2212x1659. 45° FOV — 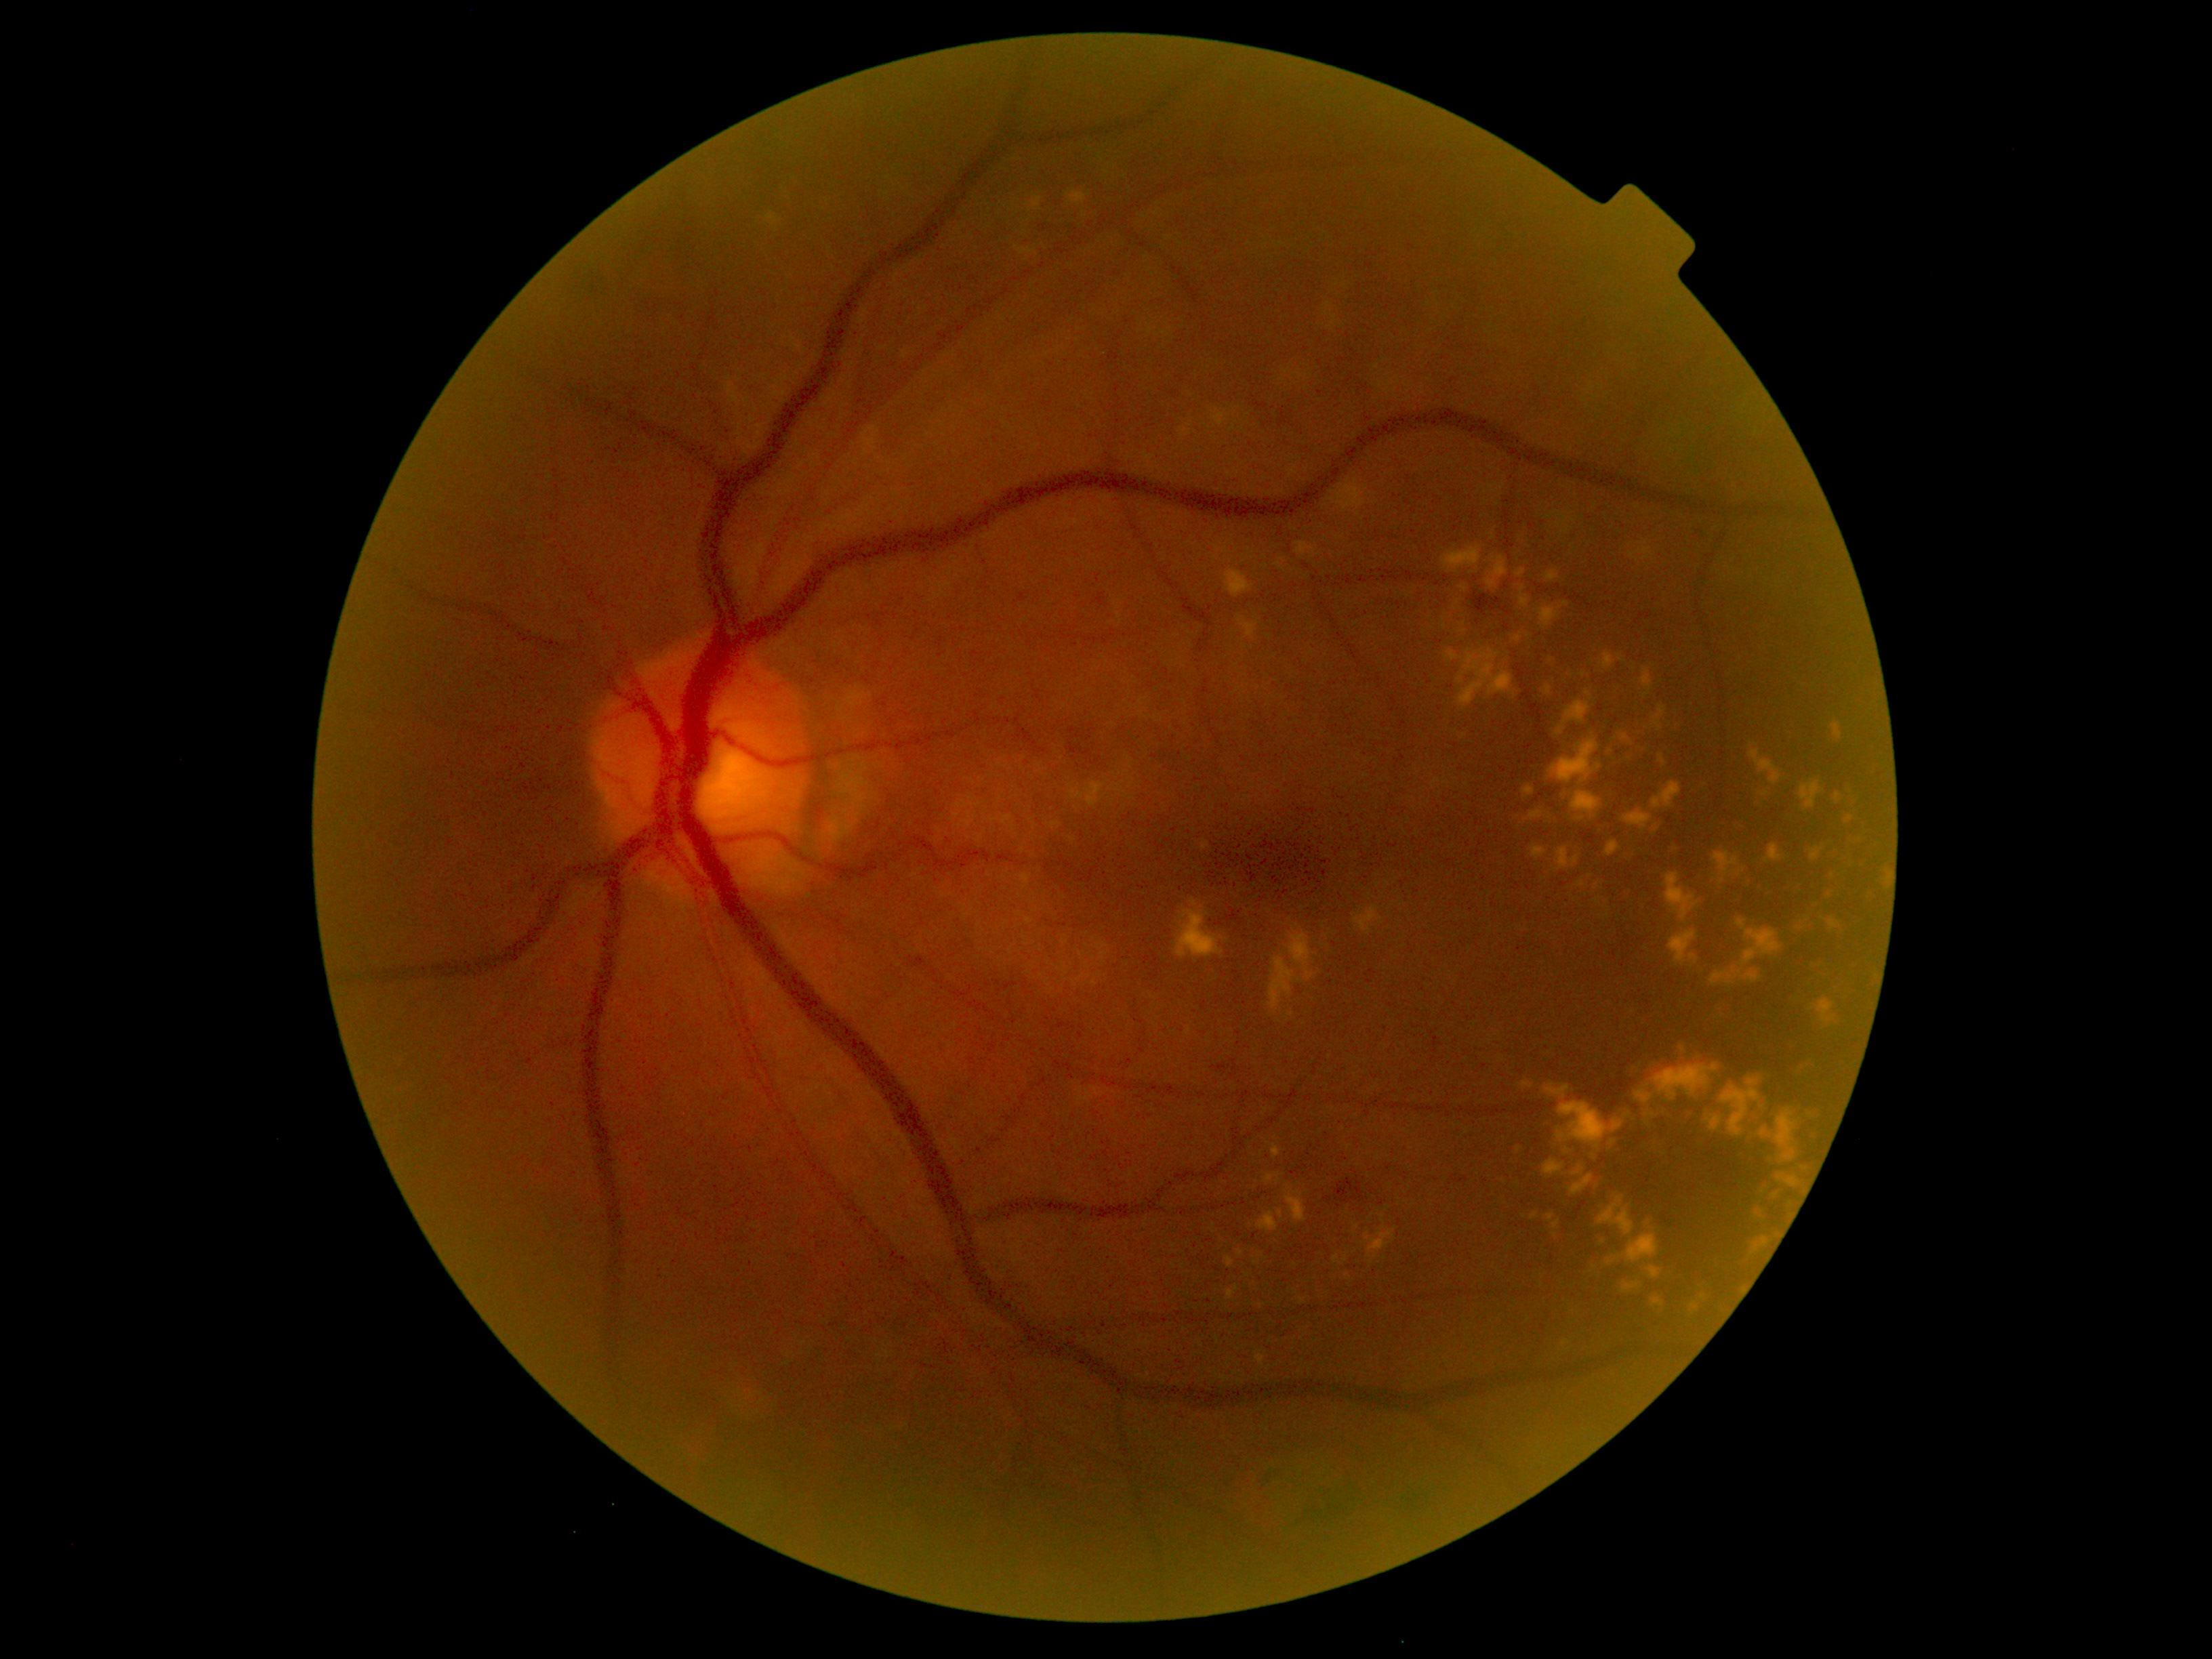
{"partial": true, "dr_grade": 2, "lesions": {"ex": [[1565, 669, 1586, 685], [766, 213, 779, 224], [1212, 410, 1226, 428], [1539, 654, 1559, 676], [1070, 783, 1107, 808], [1658, 754, 1666, 765], [1238, 616, 1260, 639], [1549, 1214, 1561, 1229], [1749, 750, 1782, 785], [1586, 691, 1592, 699], [1029, 197, 1043, 212], [1174, 899, 1226, 959], [1688, 955, 1699, 964], [1665, 874, 1699, 922], [1793, 1057, 1825, 1080]], "ex_small": [[1349, 1276], [1682, 1049], [1387, 1208], [1263, 1307]]}}